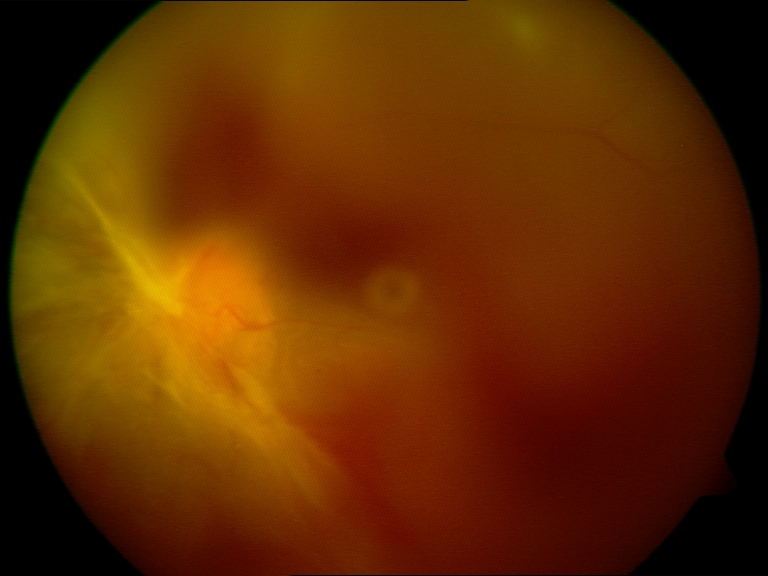

Image quality: significantly degraded.
Proliferative retinopathy: features suspicious.